Color fundus photograph: 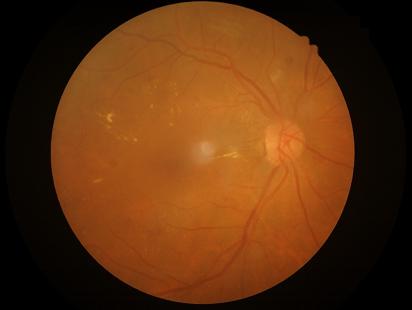 Image quality is adequate for diagnostic use. No over- or under-exposure. Vessels and details are readily distinguishable. Optic disc, vessels, and background are in focus.